FOV: 45 degrees — 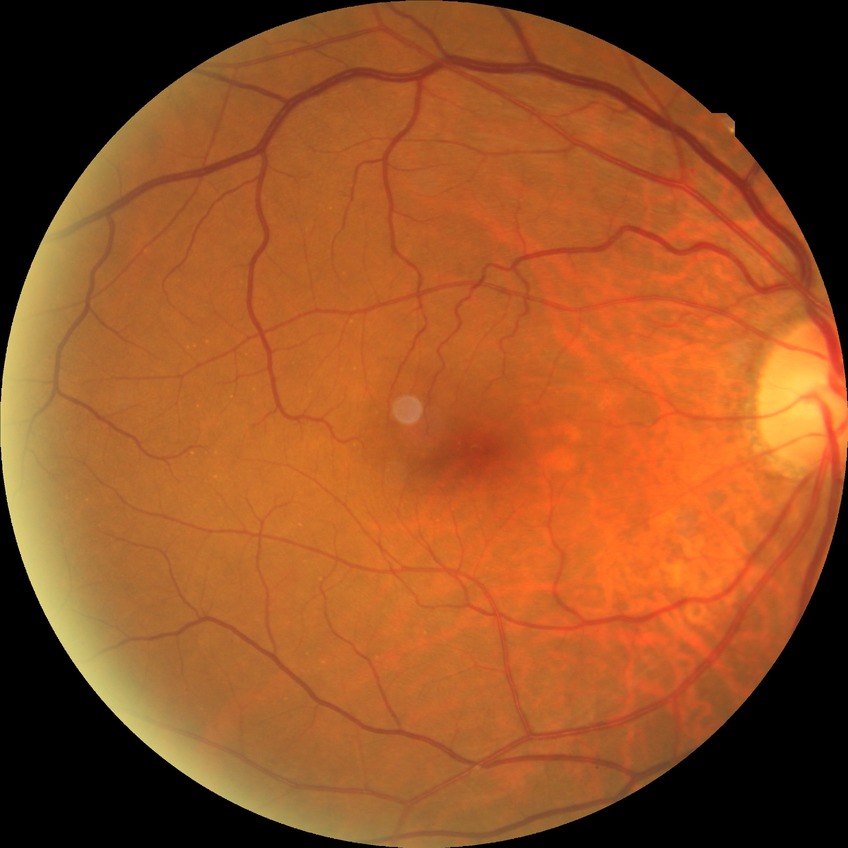
Diabetic retinopathy (DR): NDR (no diabetic retinopathy).